Non-mydriatic fundus camera, 240x240px, captured on a Nidek AFC-330 fundus camera — 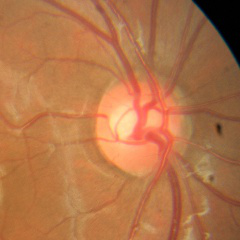
Color fundus photograph showing no glaucomatous findings.